Modified Davis classification:
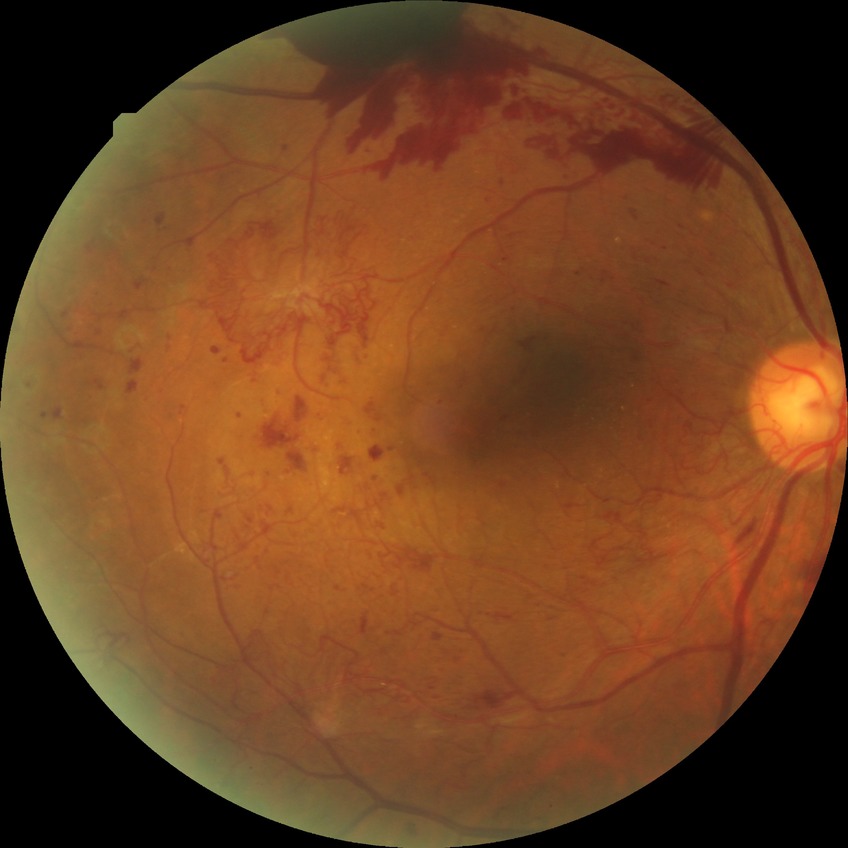
modified Davis grade: PDR.